Wide-field fundus image from infant ROP screening.
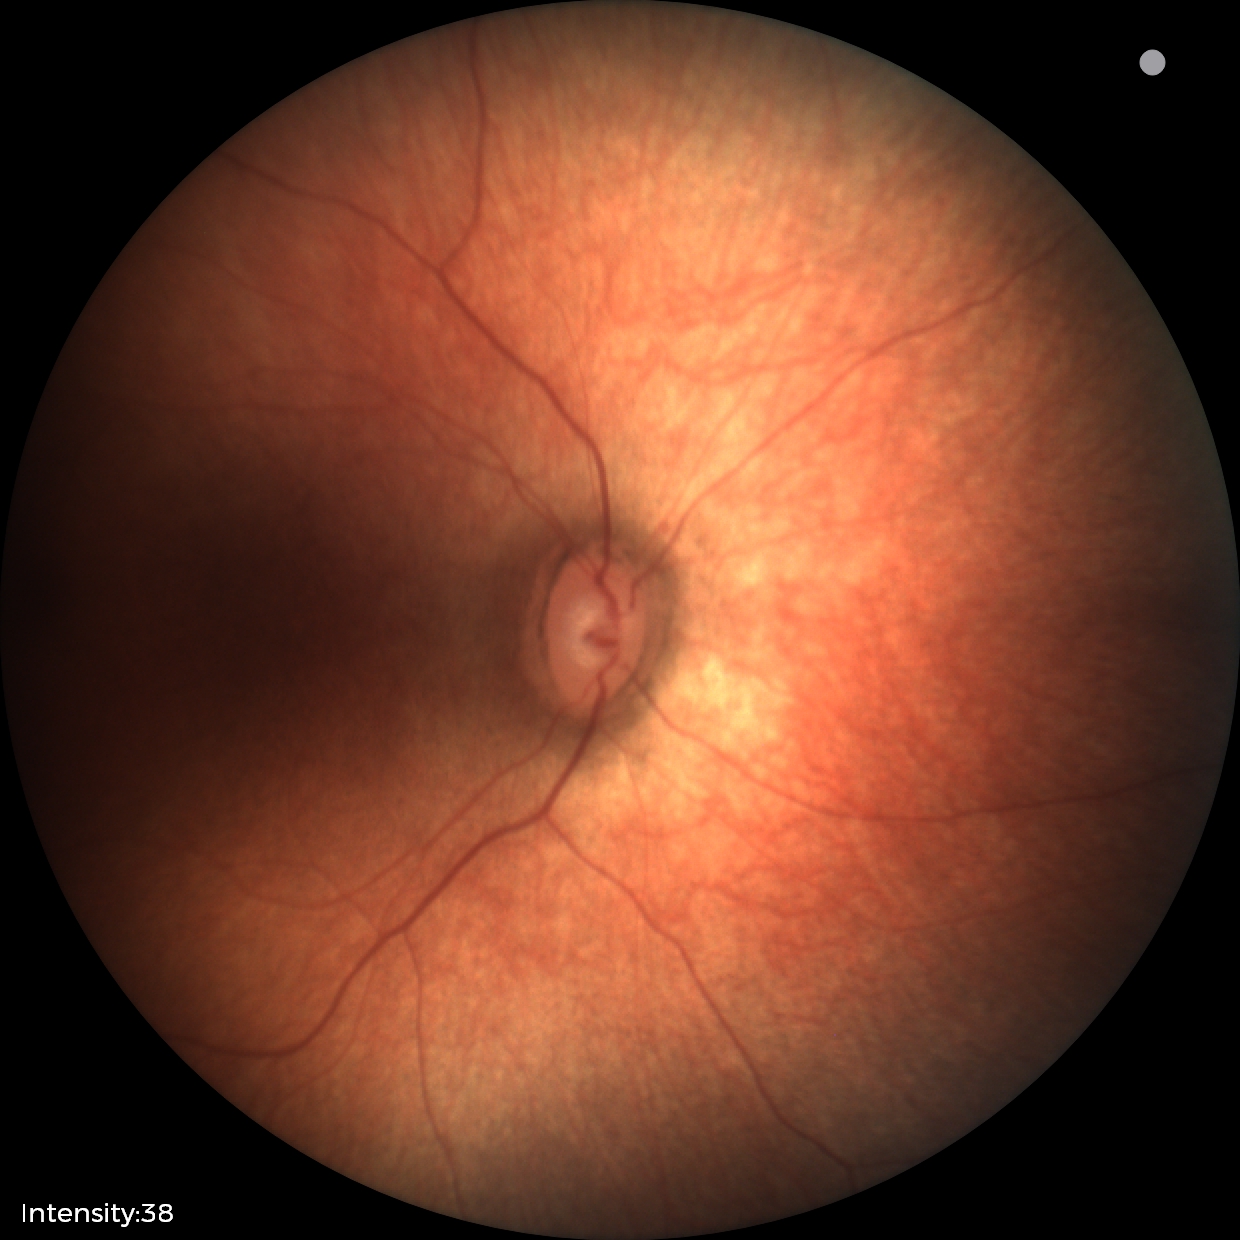

Screening examination diagnosed as physiological.